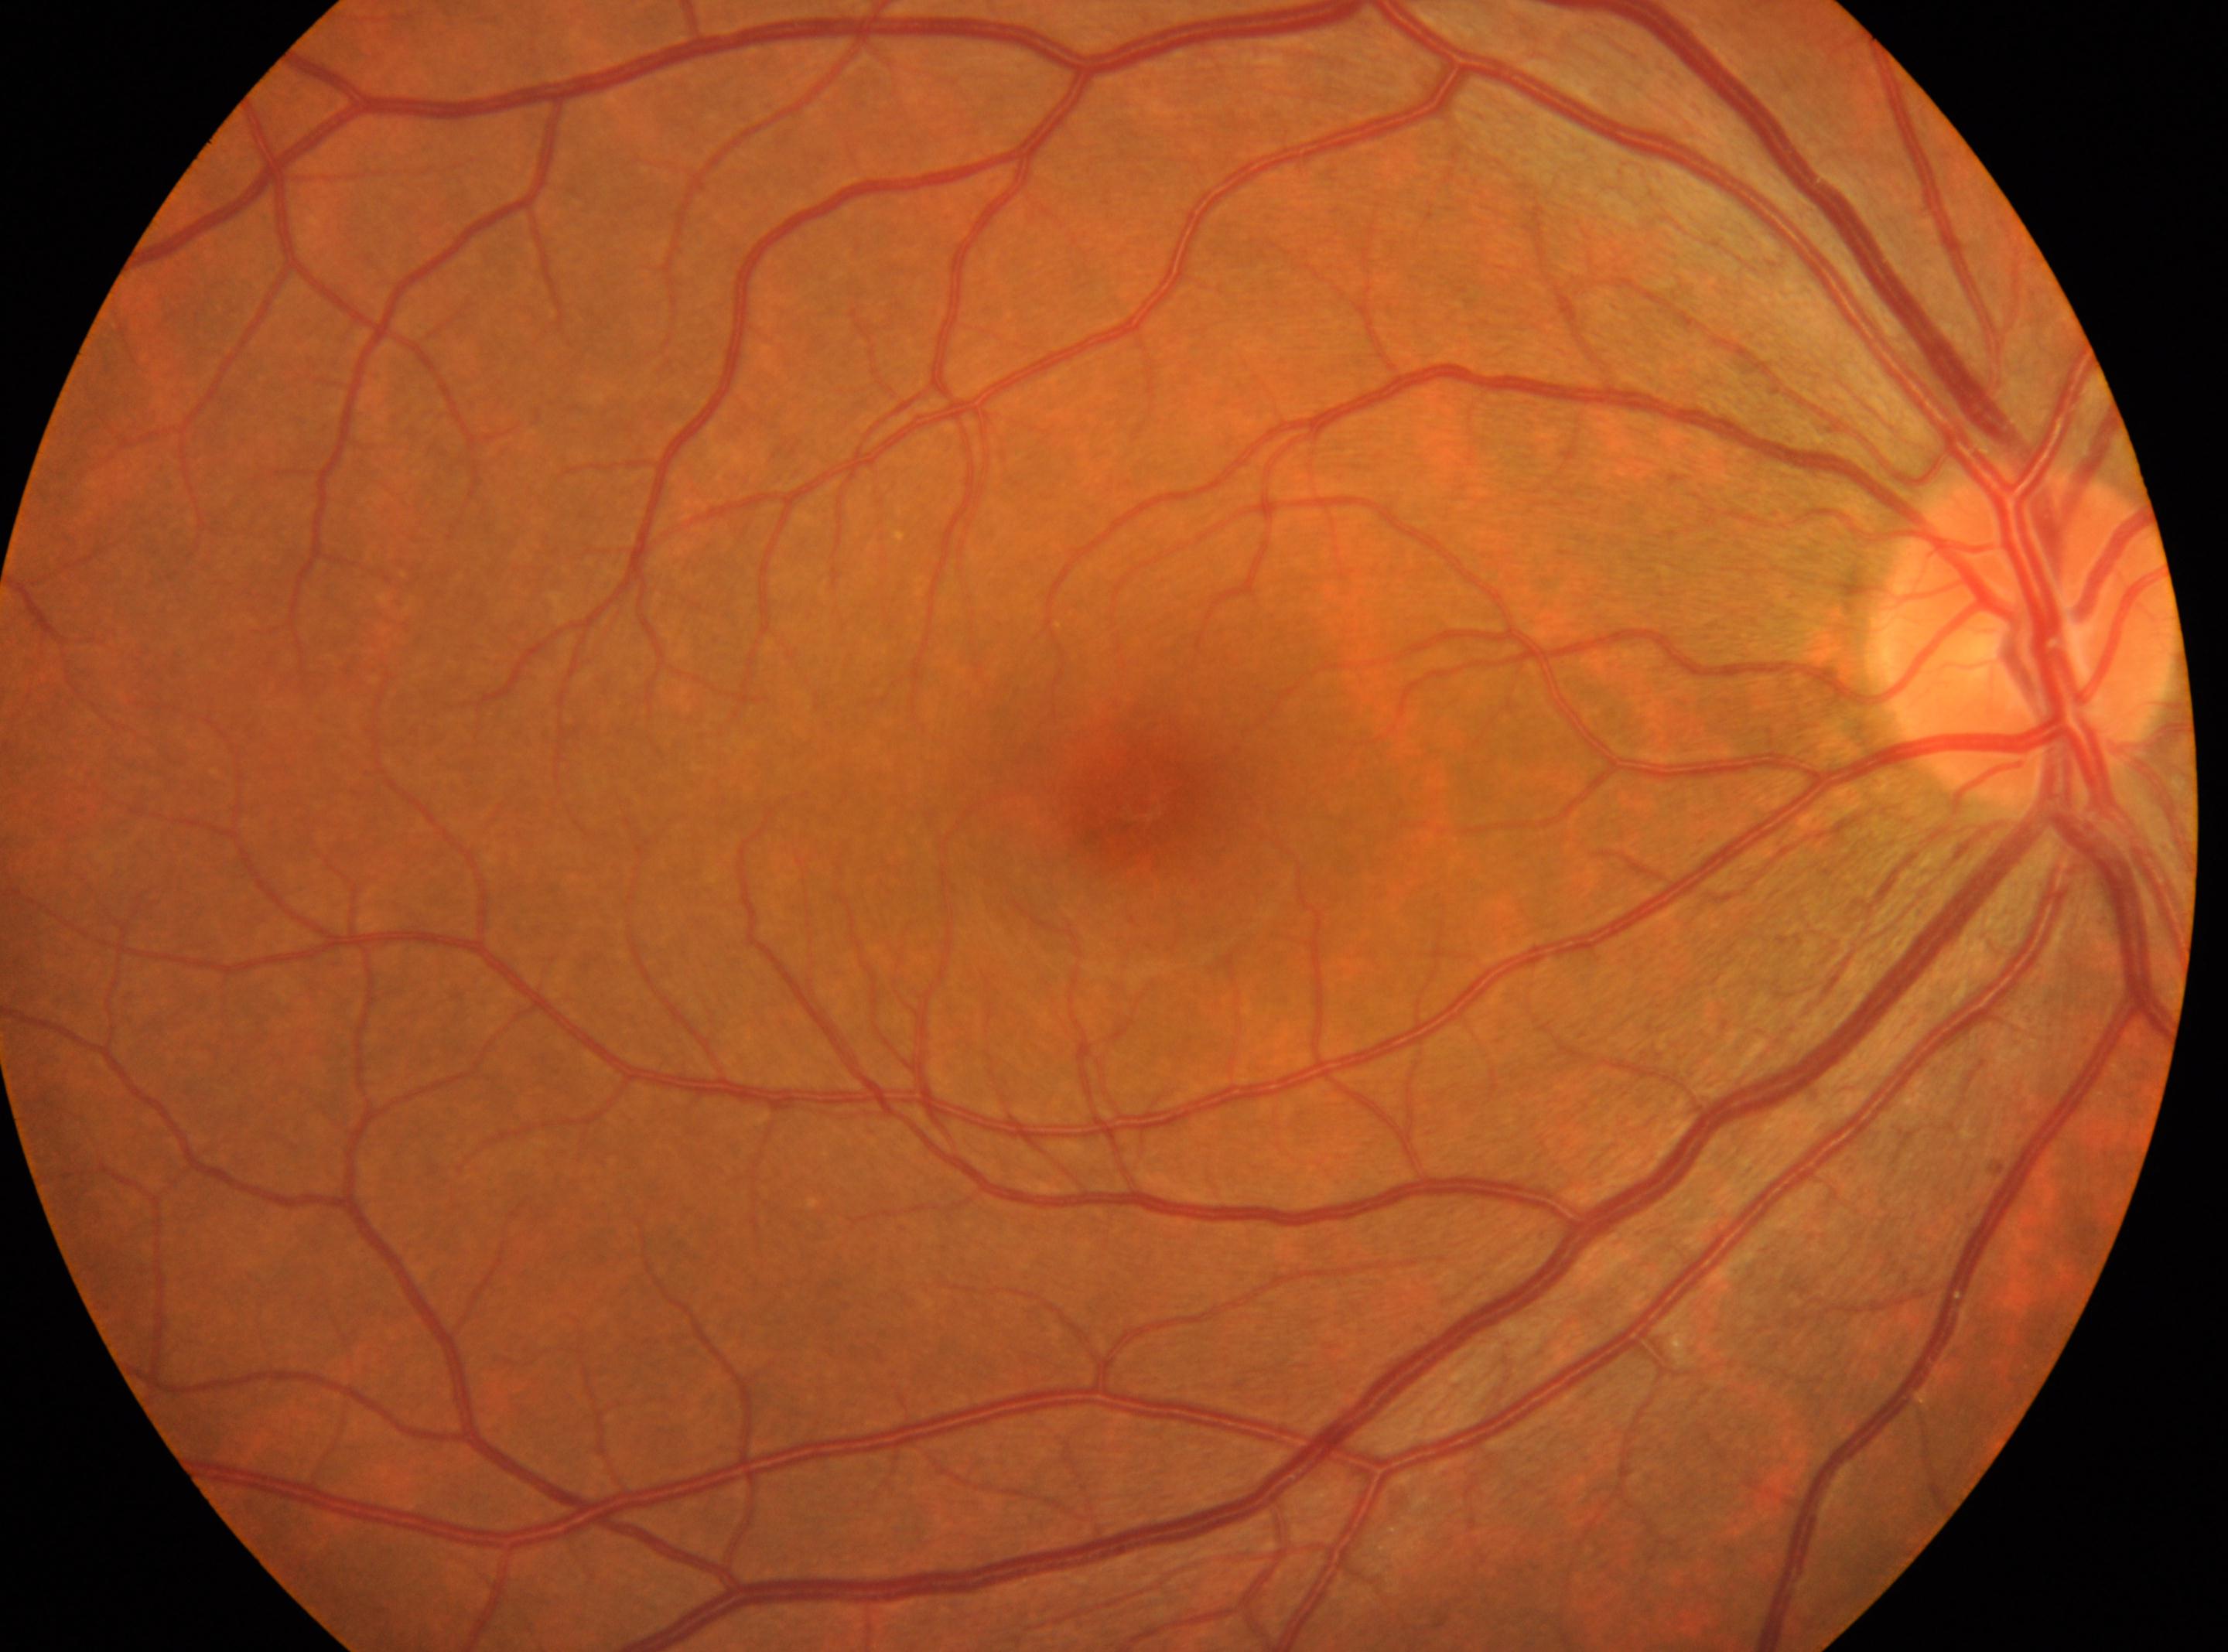
Annotations:
• diabetic retinopathy (DR) · no apparent retinopathy (grade 0)
• macular center · (1145,798)
• optic disc center · (2027,633)
• eye · OD